RetCam wide-field infant fundus image: 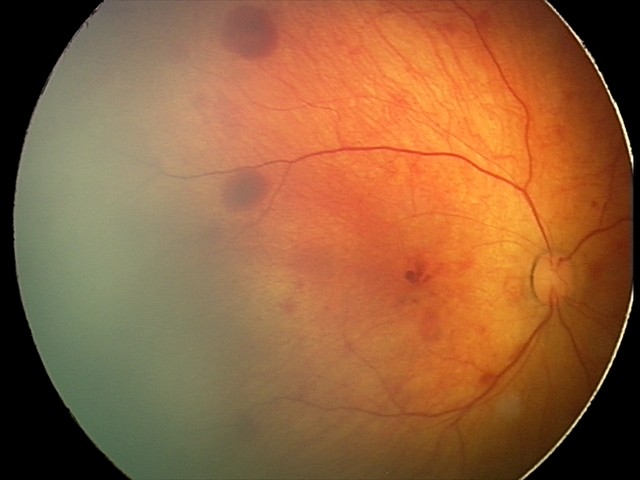

Finding: retinal hemorrhages.